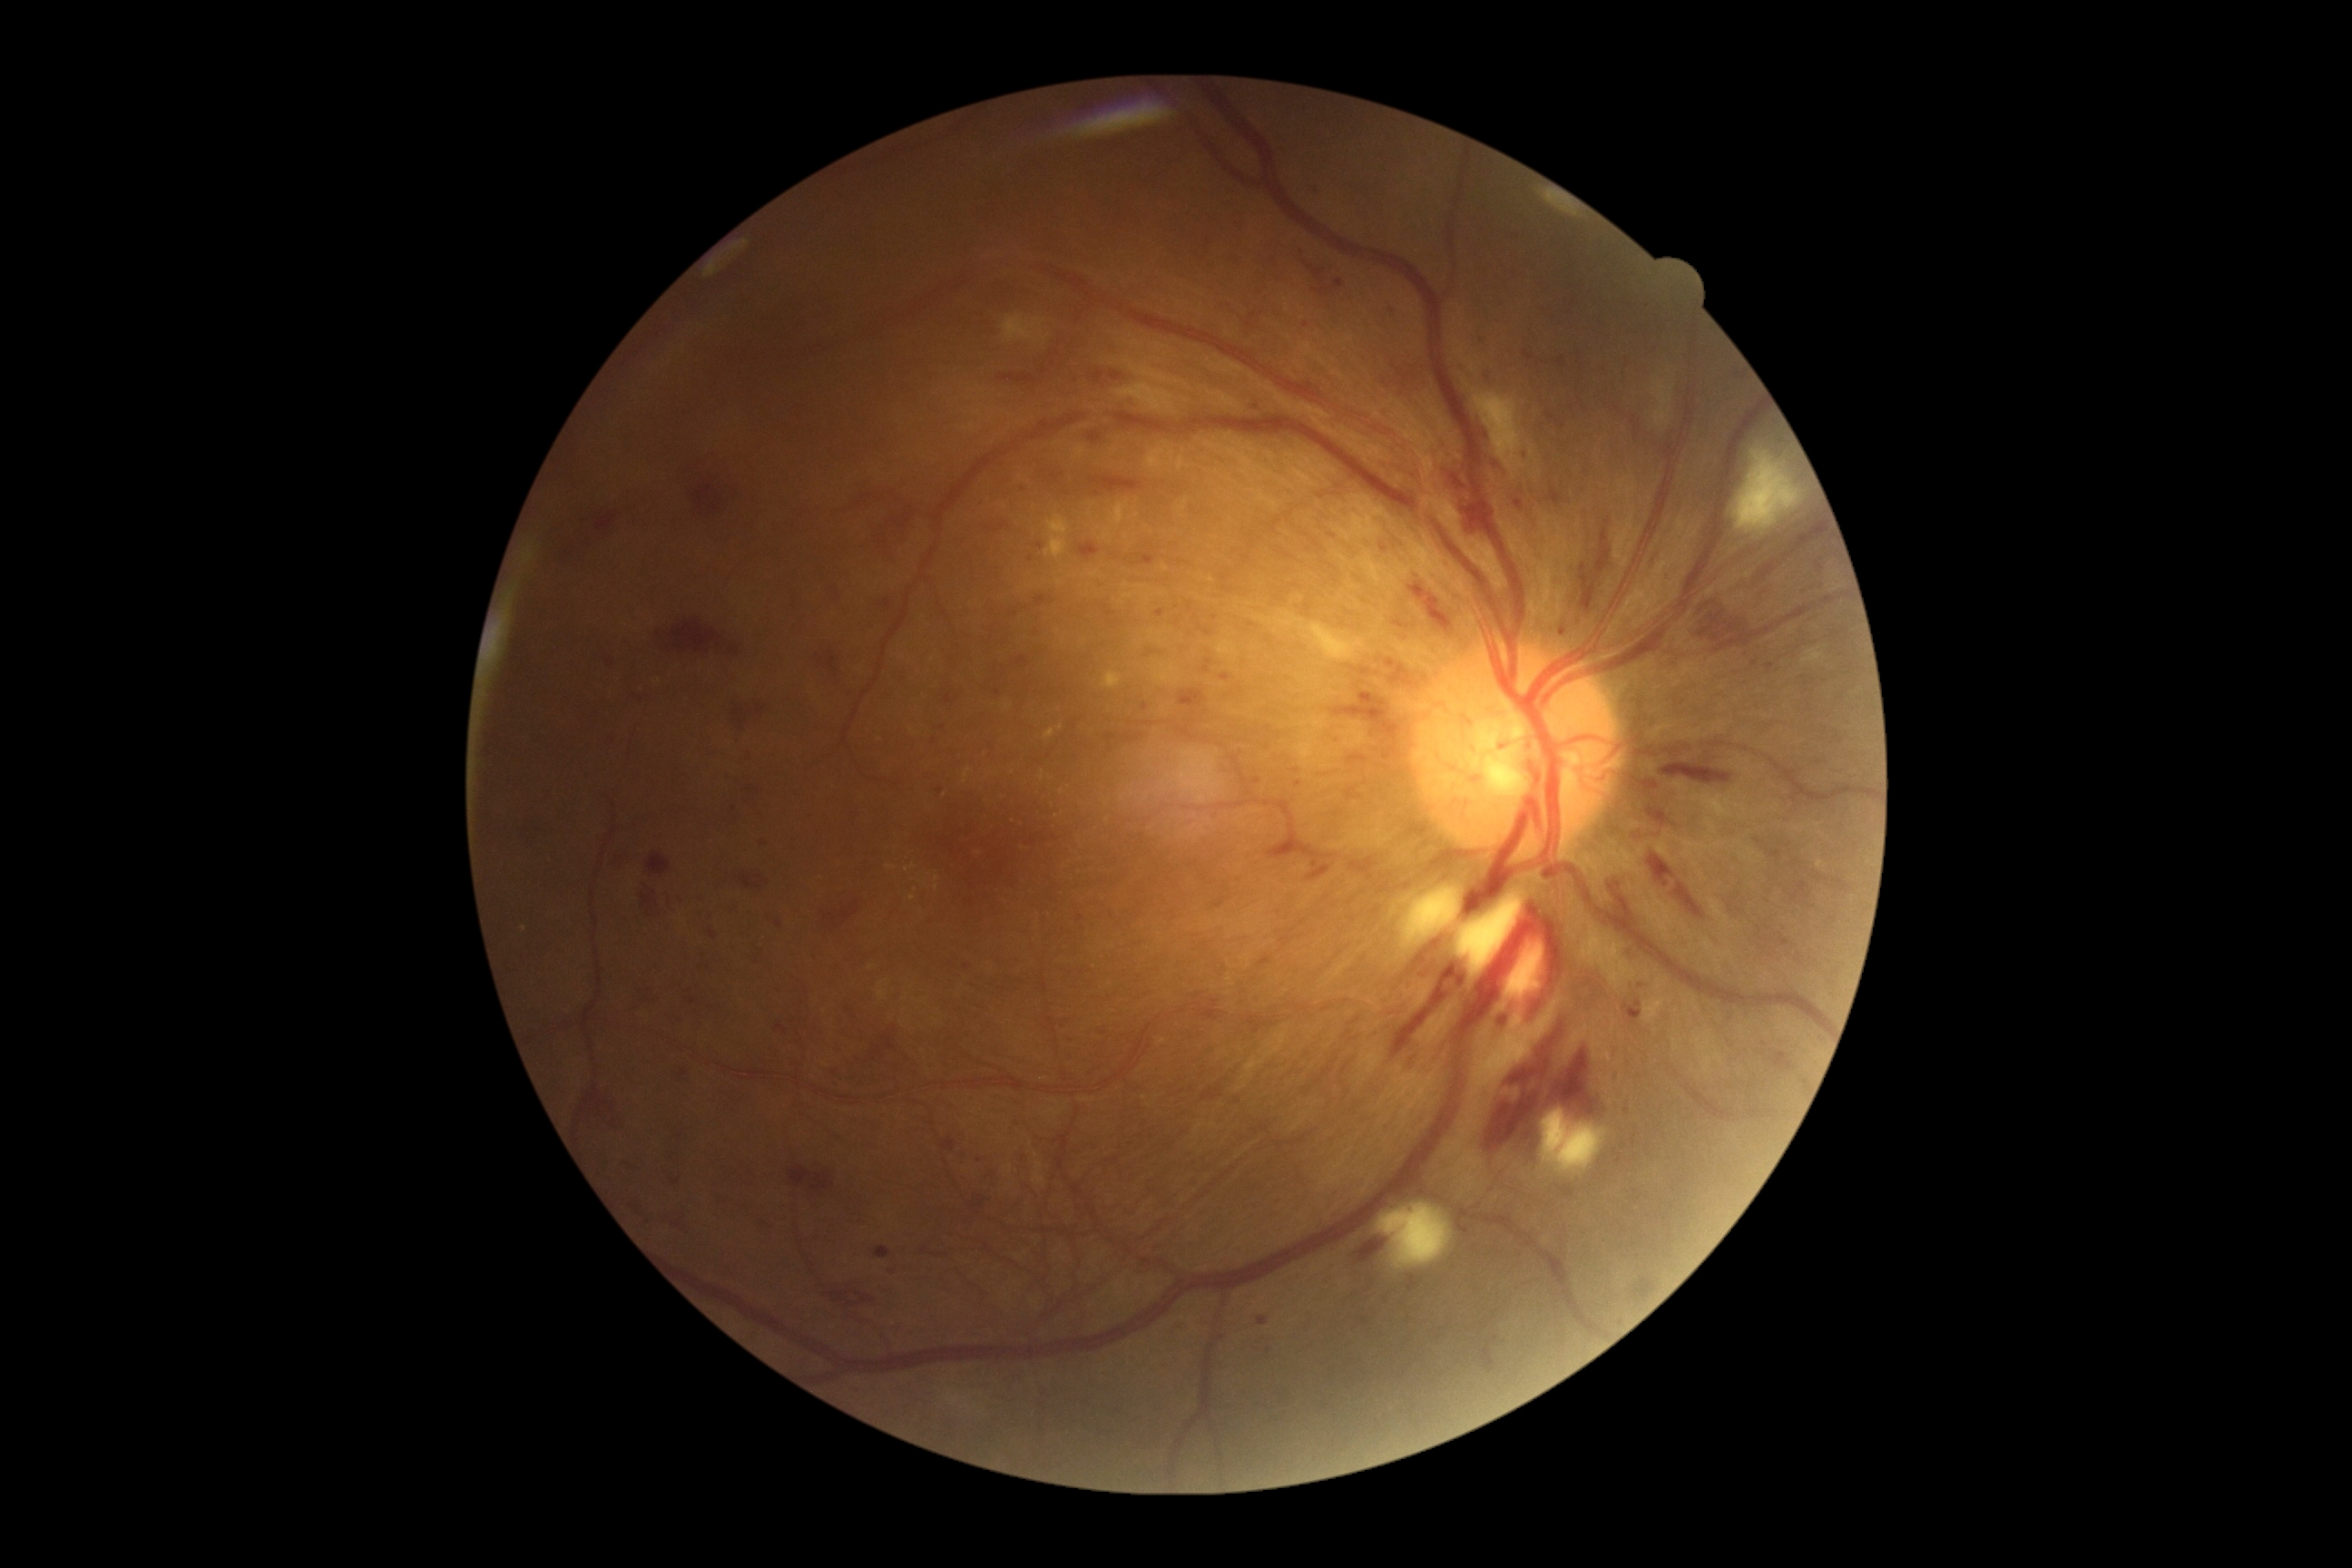 DR severity: grade 3 (severe NPDR).